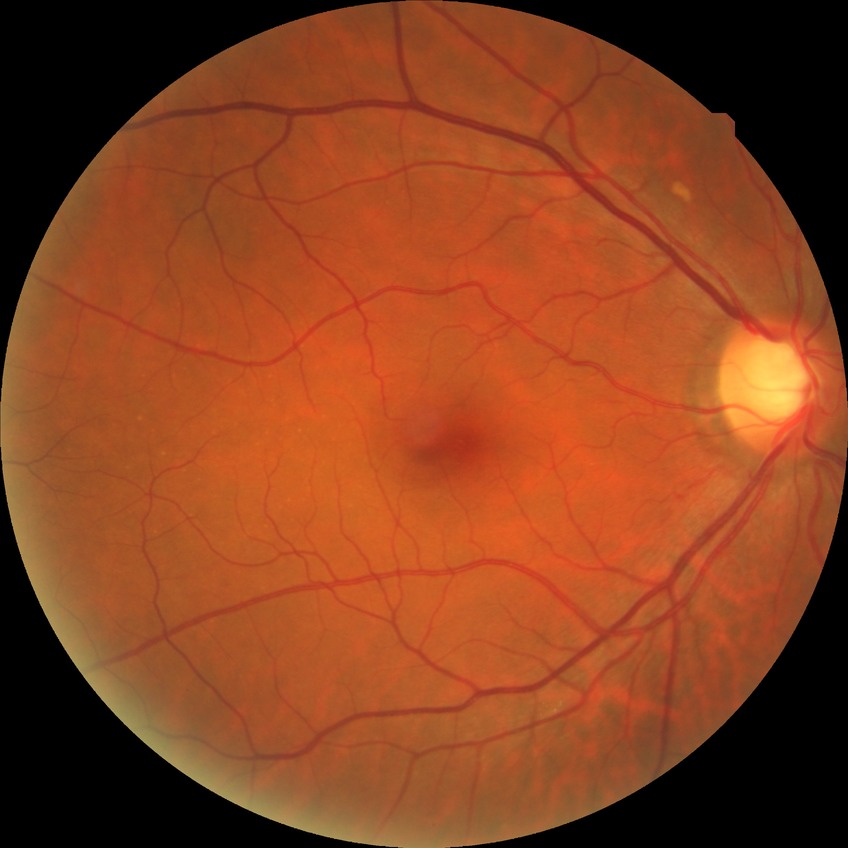

Diabetic retinopathy stage is no diabetic retinopathy.